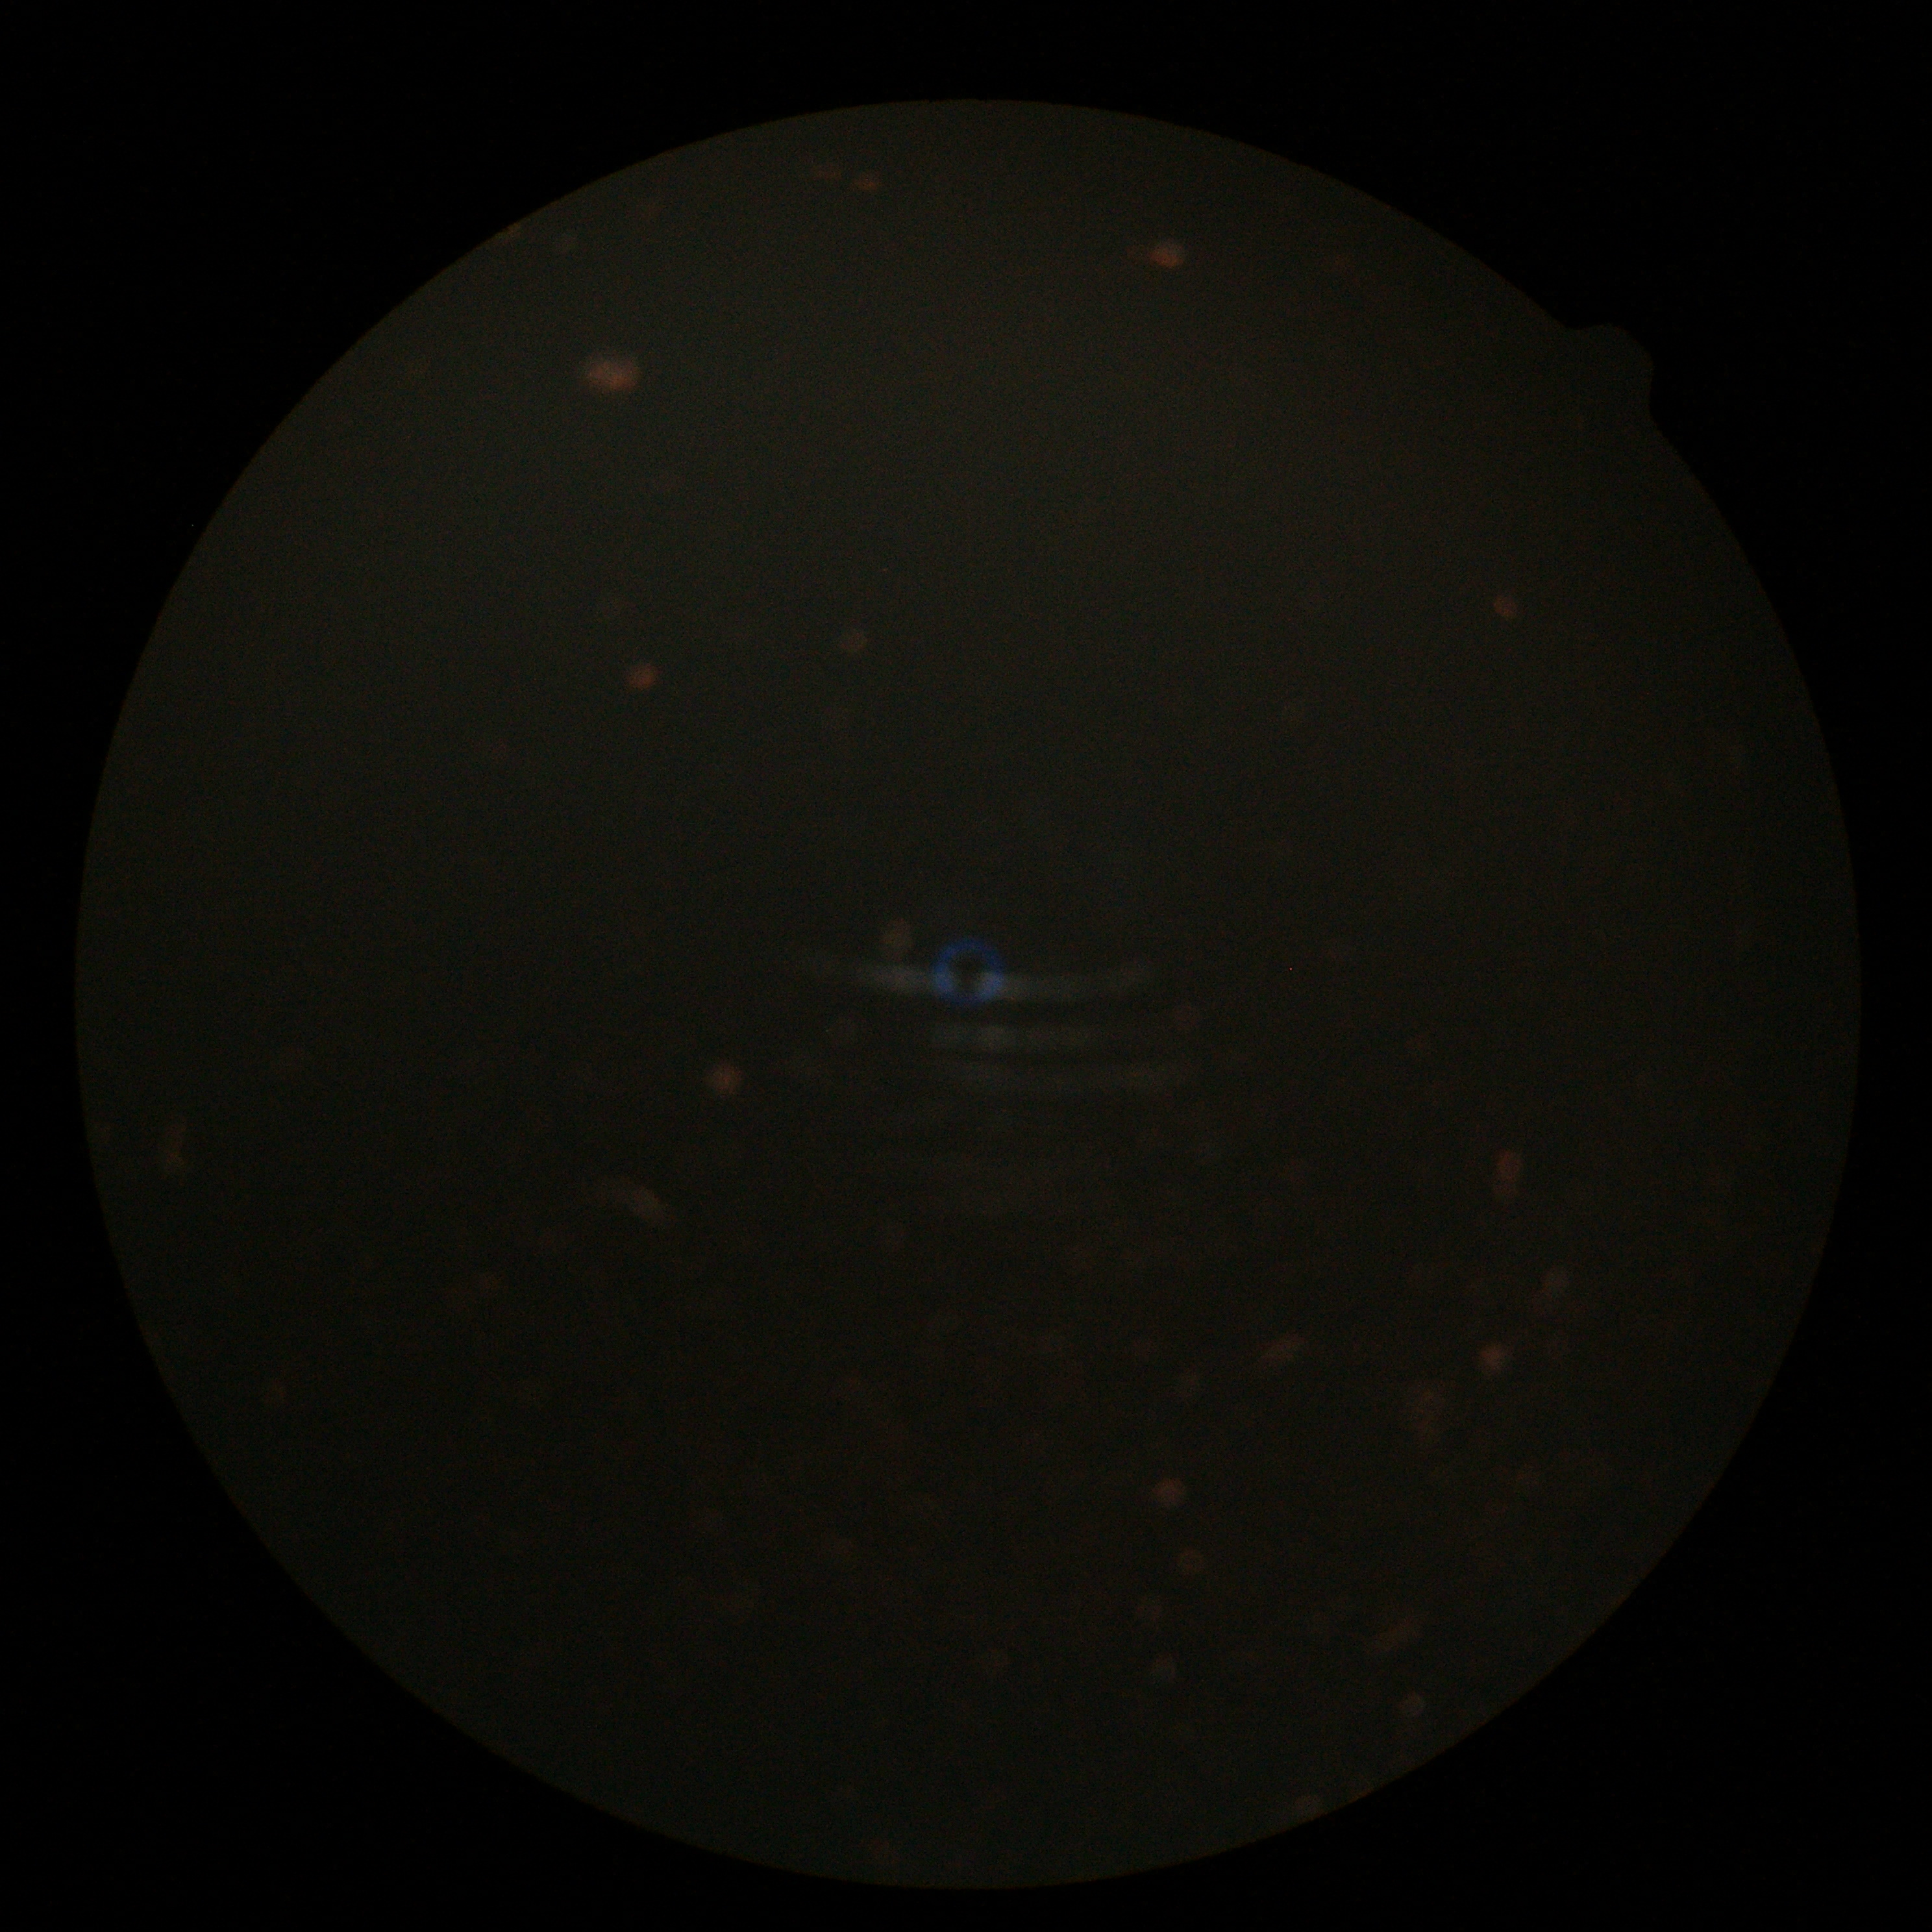   quality: too poor for DR grading
  dr_grade: ungradable